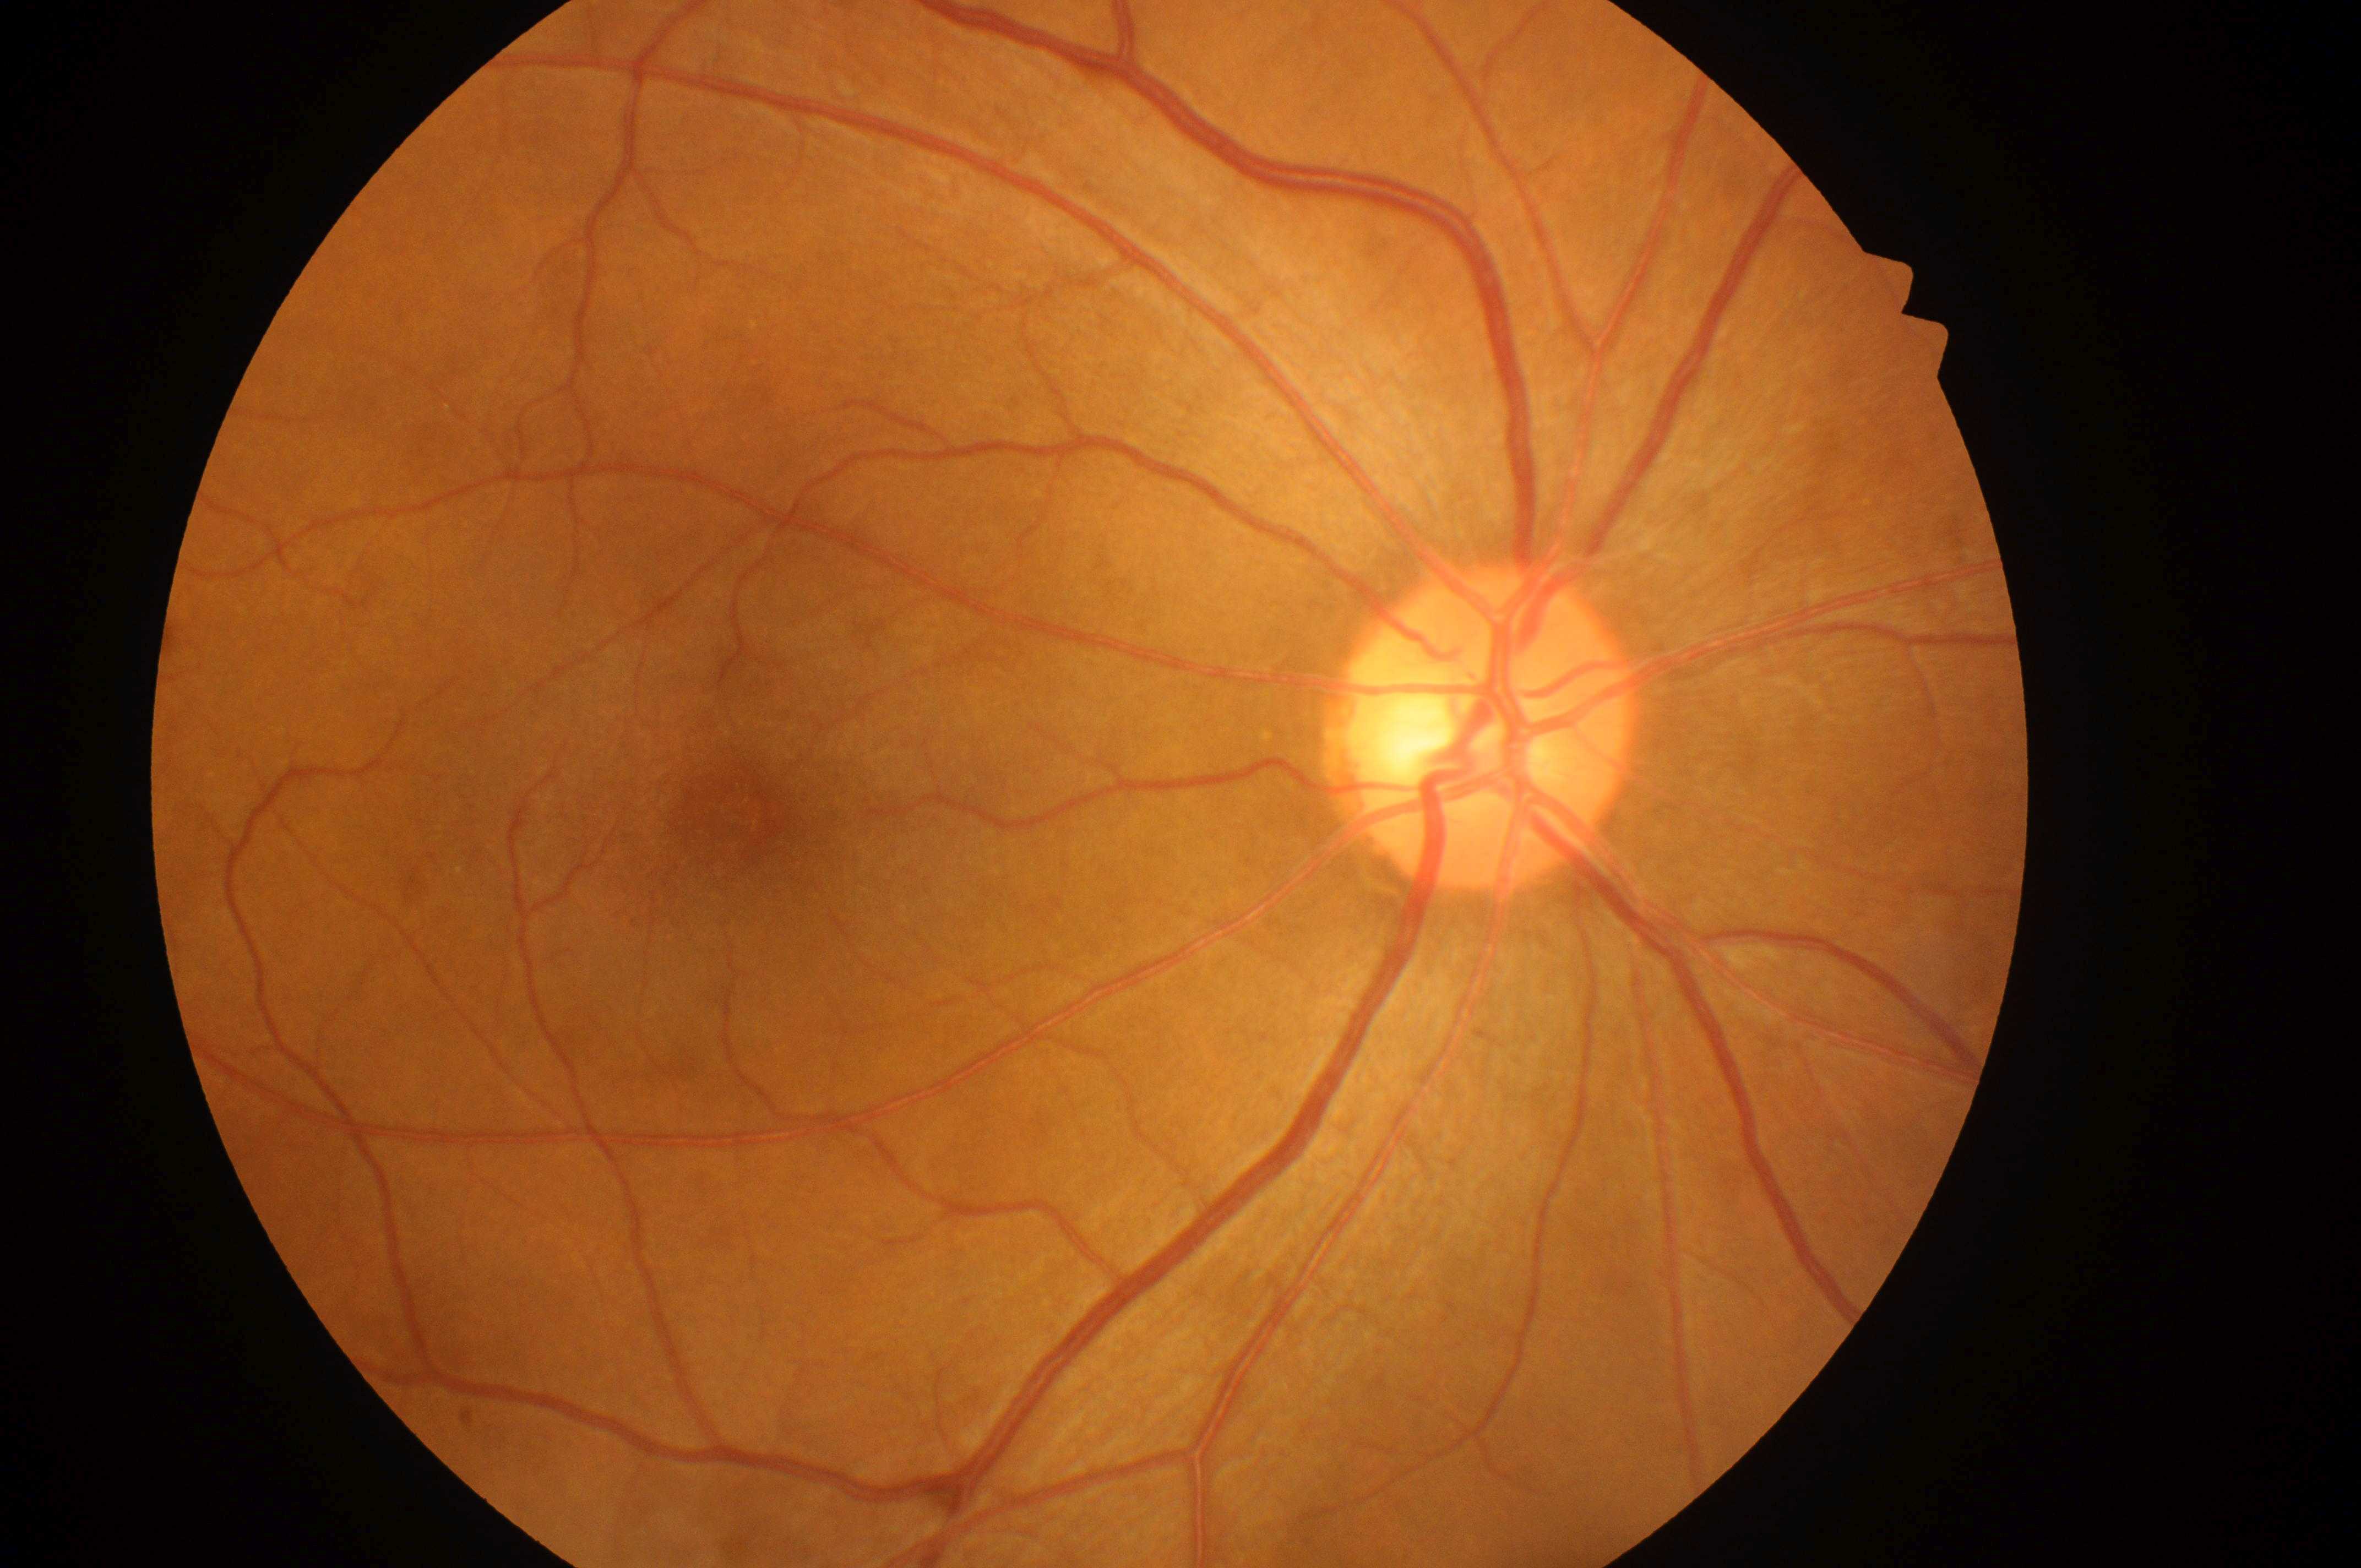 This is the OD.
DME is no risk (grade 0).
Optic disc center located at x=1481, y=740.
Fovea centralis located at x=726, y=818.
DR: mild NPDR (grade 1).